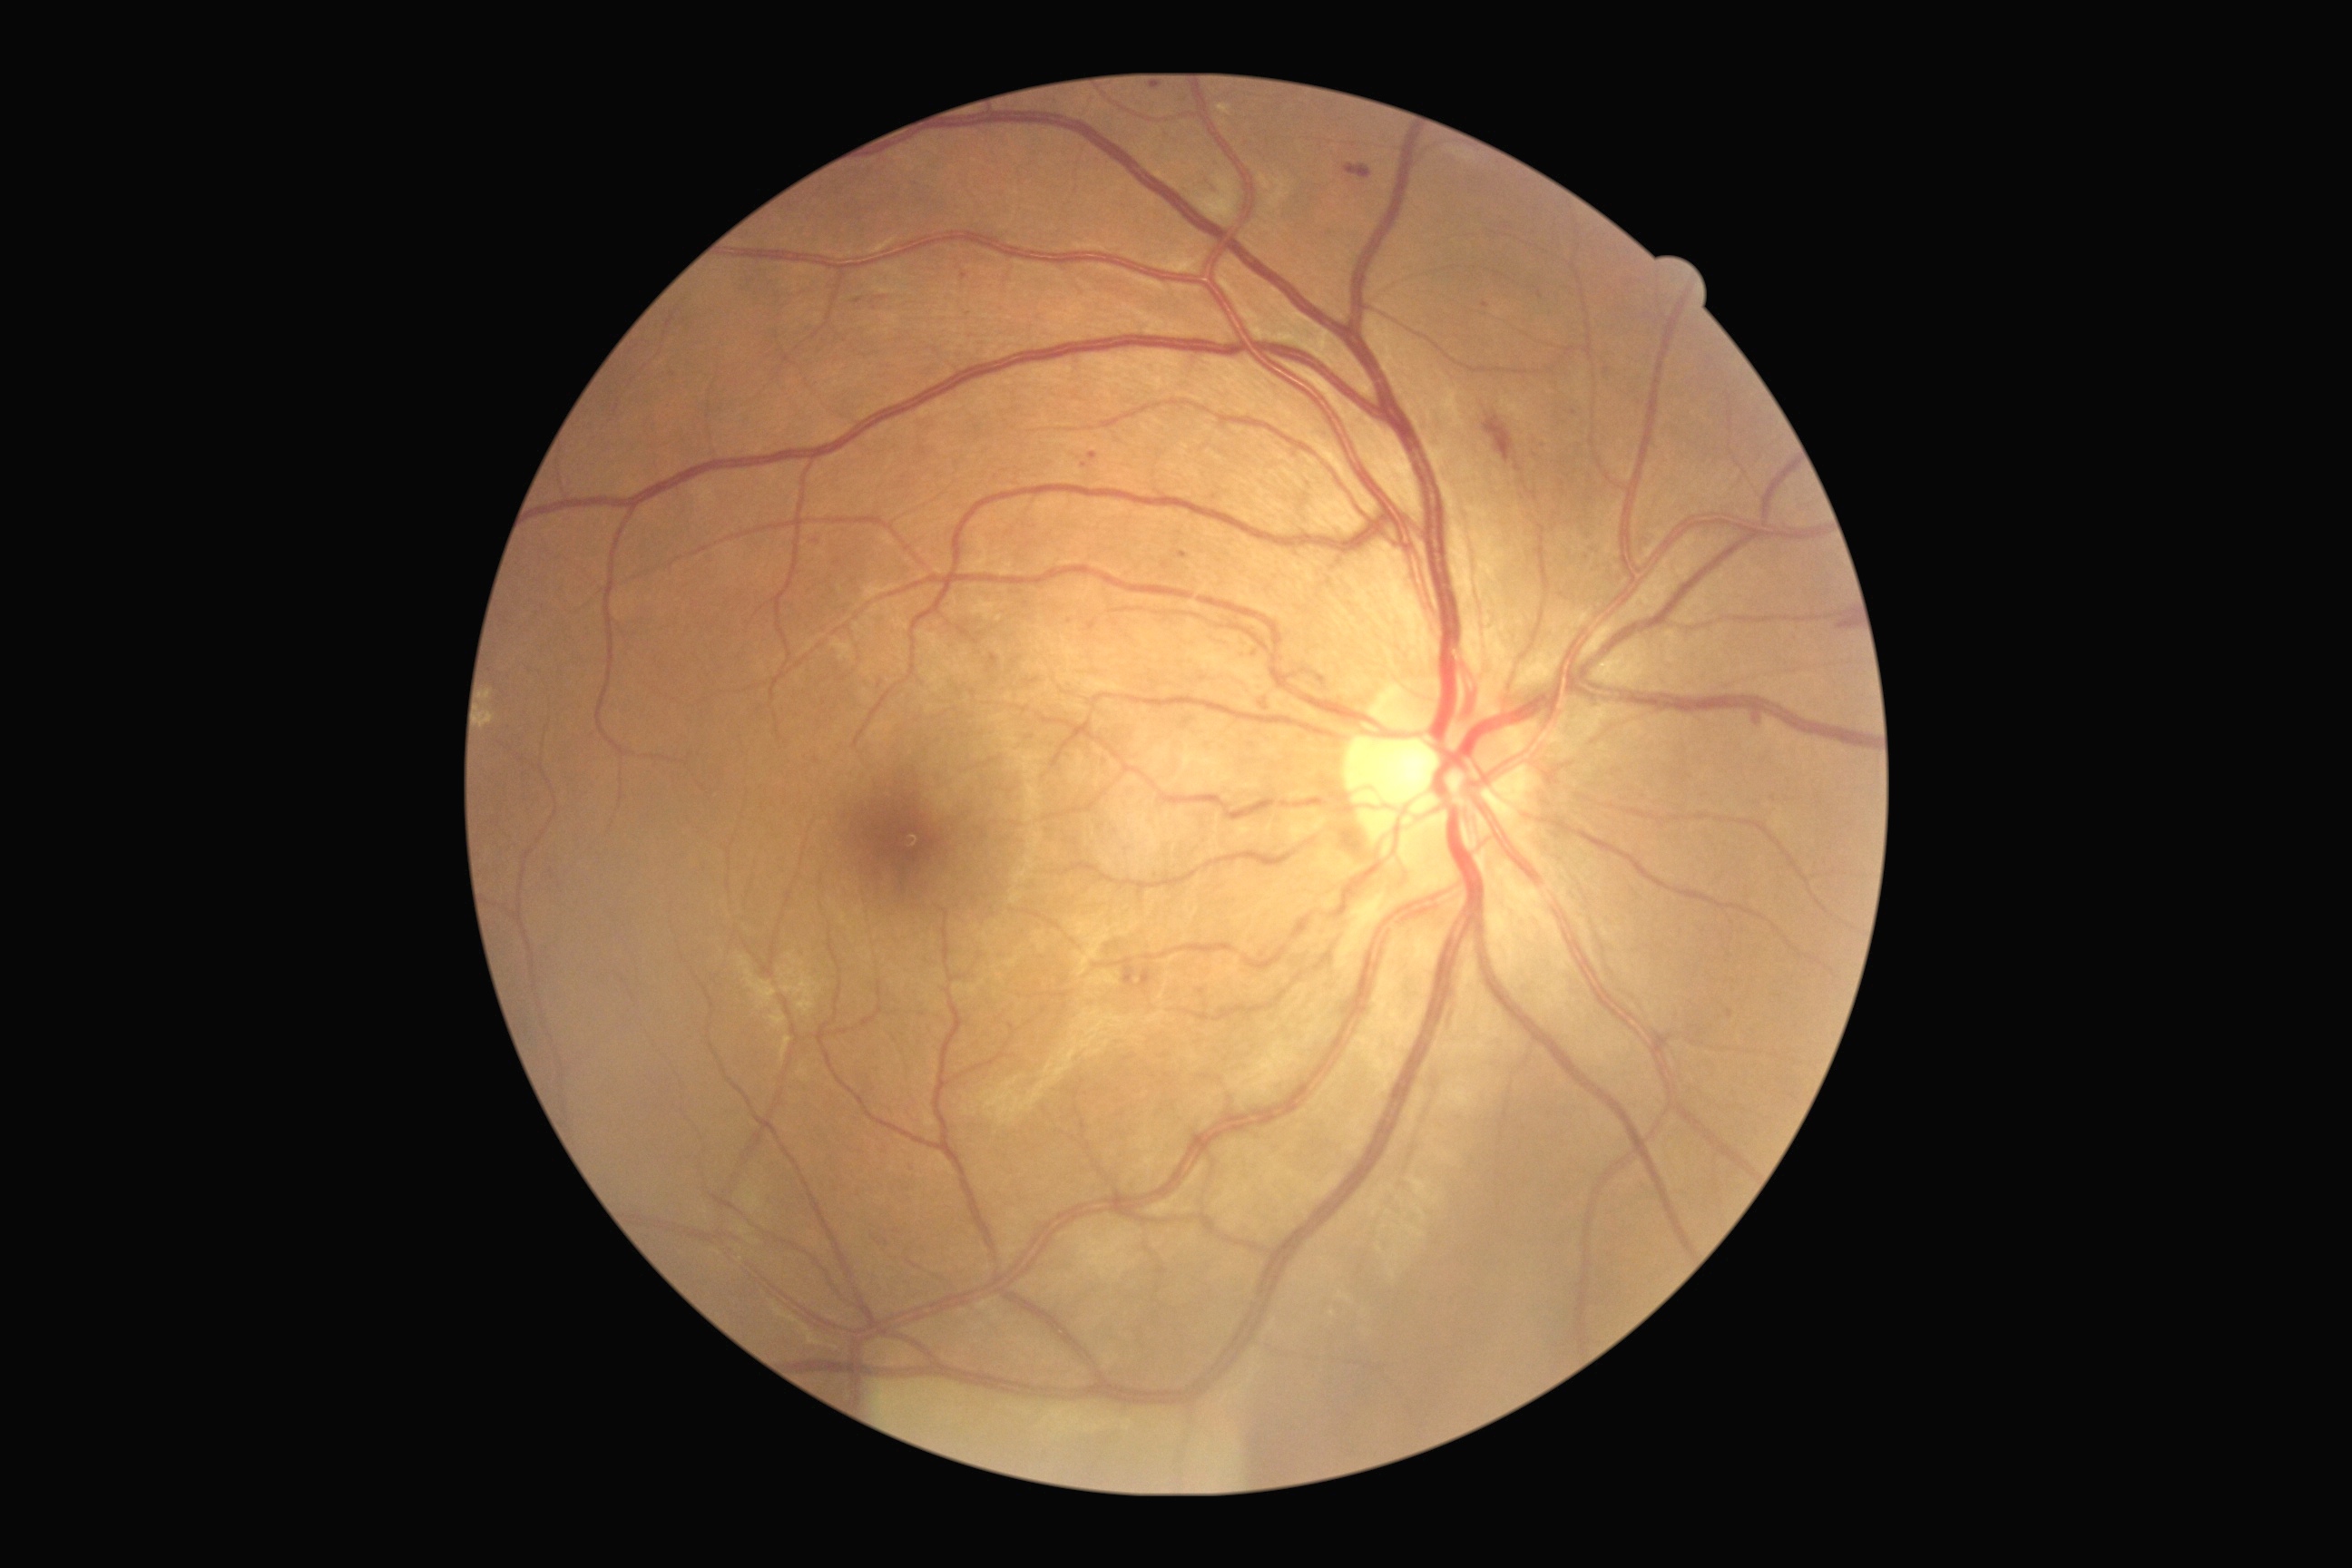
{
  "dr_grade": "2/4"
}